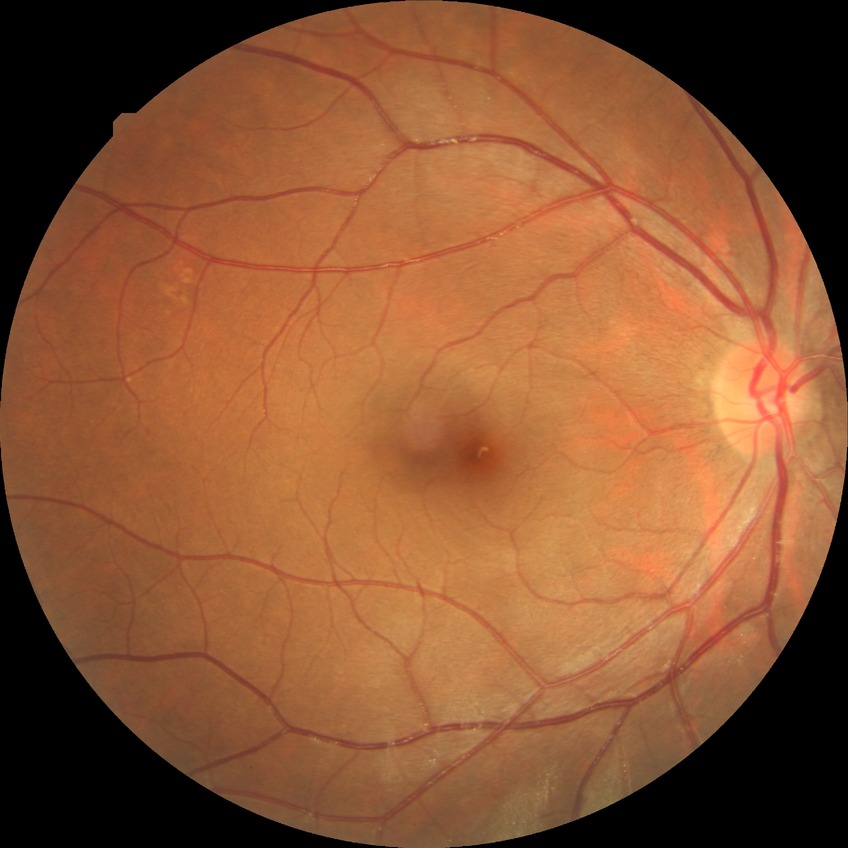
Diabetic retinopathy (DR) is NDR (no diabetic retinopathy).